Color fundus image, 45-degree field of view — 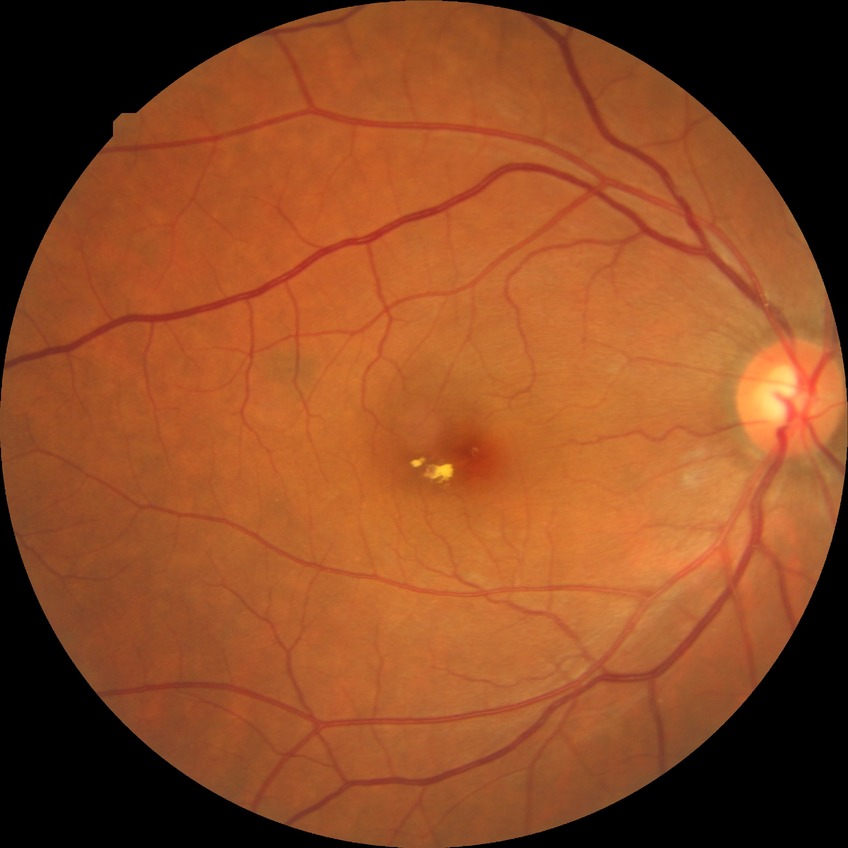 DR class=non-proliferative diabetic retinopathy, DR grade=SDR.